DR severity per modified Davis staging. Acquired with a NIDEK AFC-230. 848x848px: 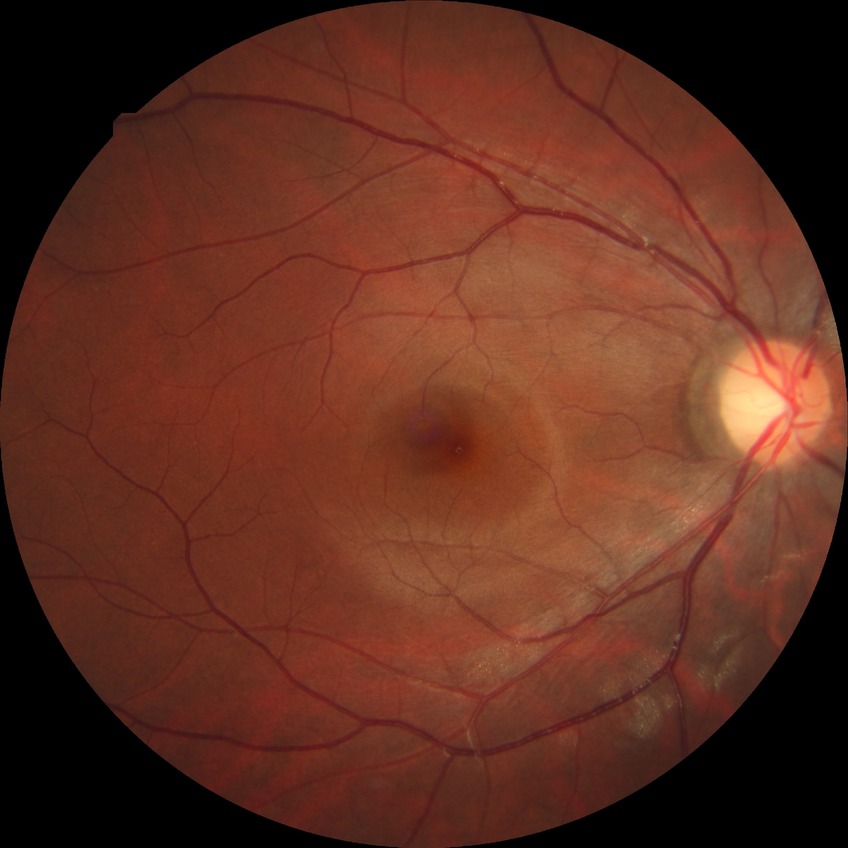   davis_grade: no diabetic retinopathy (NDR)